Camera: Clarity RetCam 3 (130° FOV) · RetCam wide-field infant fundus image.
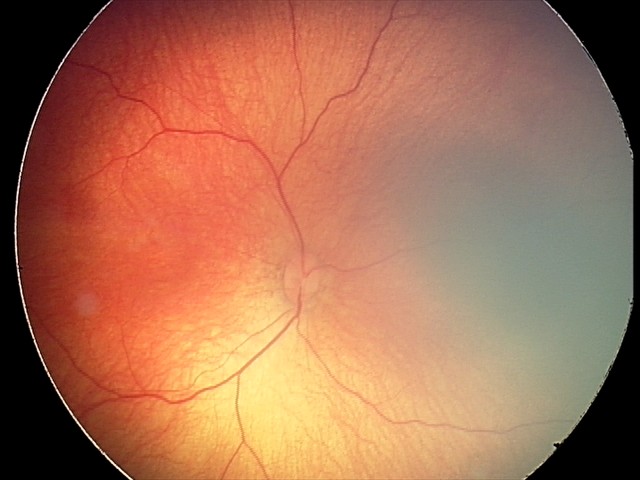 Screening examination consistent with retinal hemorrhages.